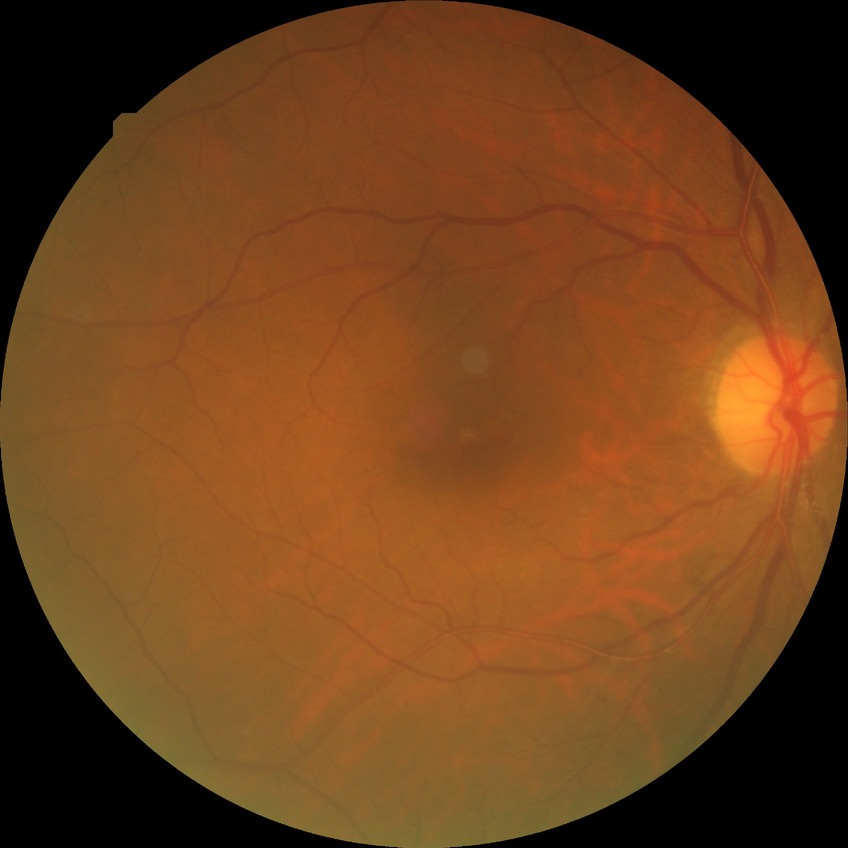 Findings:
* diabetic retinopathy (DR): simple diabetic retinopathy (SDR)